Color fundus image, acquired with a NIDEK AFC-230.
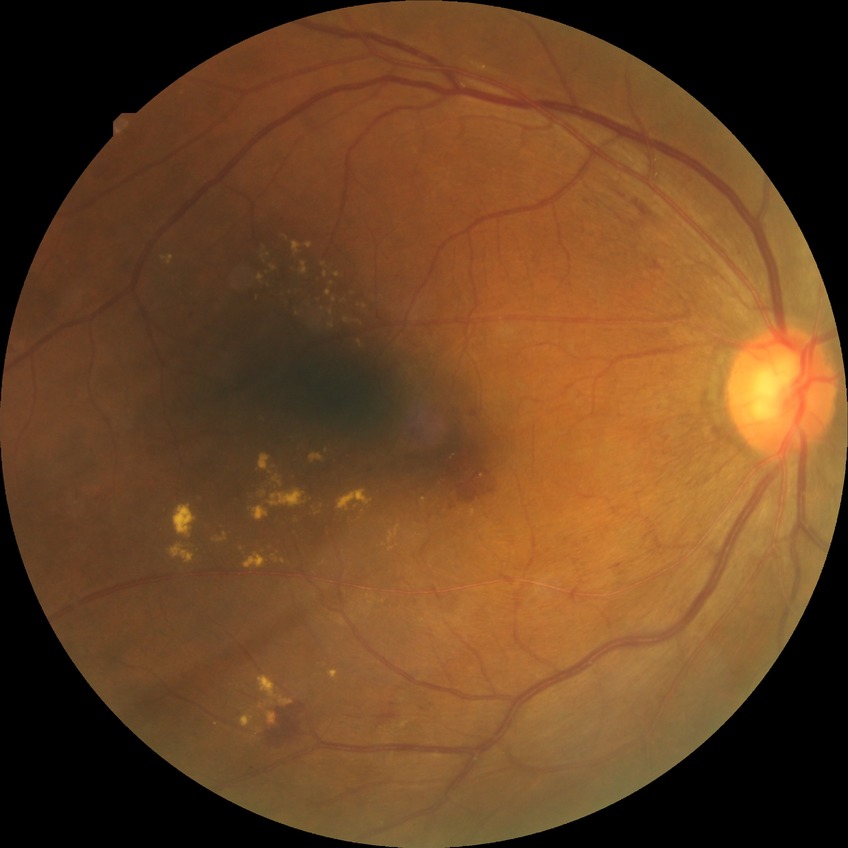
Diabetic retinopathy (DR) is PDR (proliferative diabetic retinopathy).